45-degree field of view — 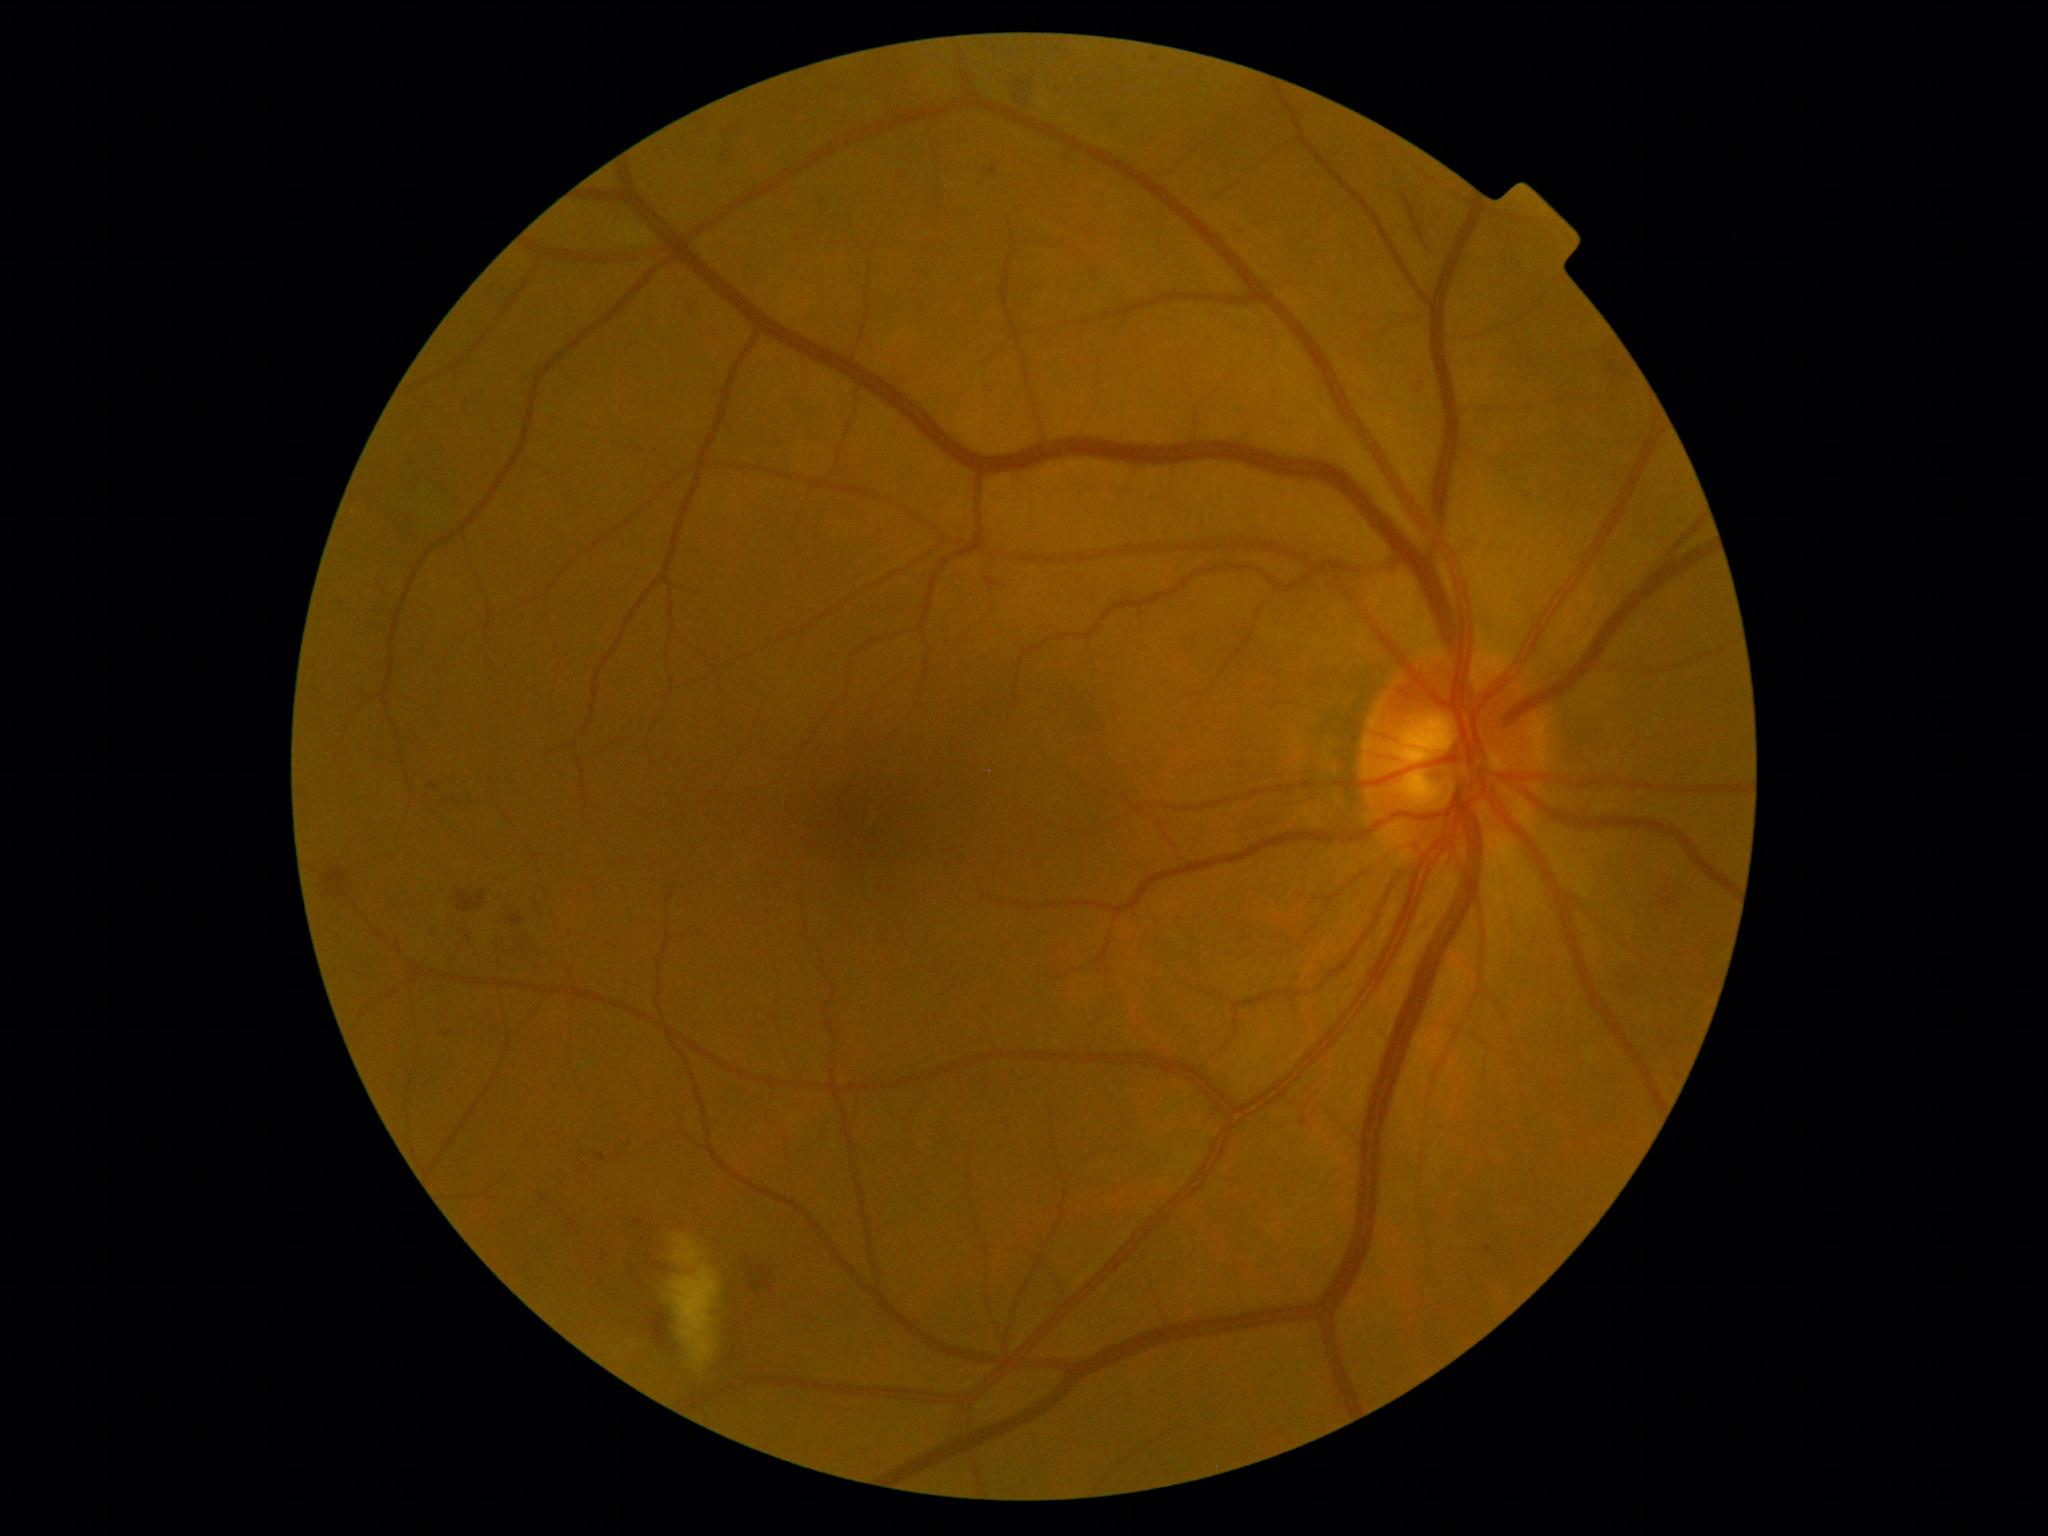
DR stage: 2
Lesions identified (partial list):
HEs: <box>627,1216,670,1273</box>; <box>1657,877,1684,915</box>; <box>720,115,743,161</box>; <box>510,915,525,926</box>; <box>536,1193,561,1212</box>; <box>1008,63,1041,110</box>; <box>647,1308,671,1348</box>; <box>746,1255,789,1292</box>; <box>320,863,347,896</box>; <box>1404,198,1424,242</box>; <box>457,890,486,912</box>; <box>1300,1081,1322,1110</box>
MAs (continued): <box>598,1154,607,1161</box>; <box>430,784,440,790</box>; <box>987,166,997,176</box>; <box>1301,1118,1310,1126</box>; <box>445,1031,453,1037</box>; <box>637,1219,644,1227</box>; <box>710,333,718,338</box>; <box>688,307,696,315</box>; <box>1609,361,1622,374</box>
Small MAs approximately at <pt>799,240</pt>; <pt>434,933</pt>; <pt>640,1284</pt>; <pt>1489,1249</pt>; <pt>496,1031</pt>; <pt>392,857</pt>; <pt>1154,59</pt>
SEs: <box>668,1235,721,1370</box>
EXs: none detected